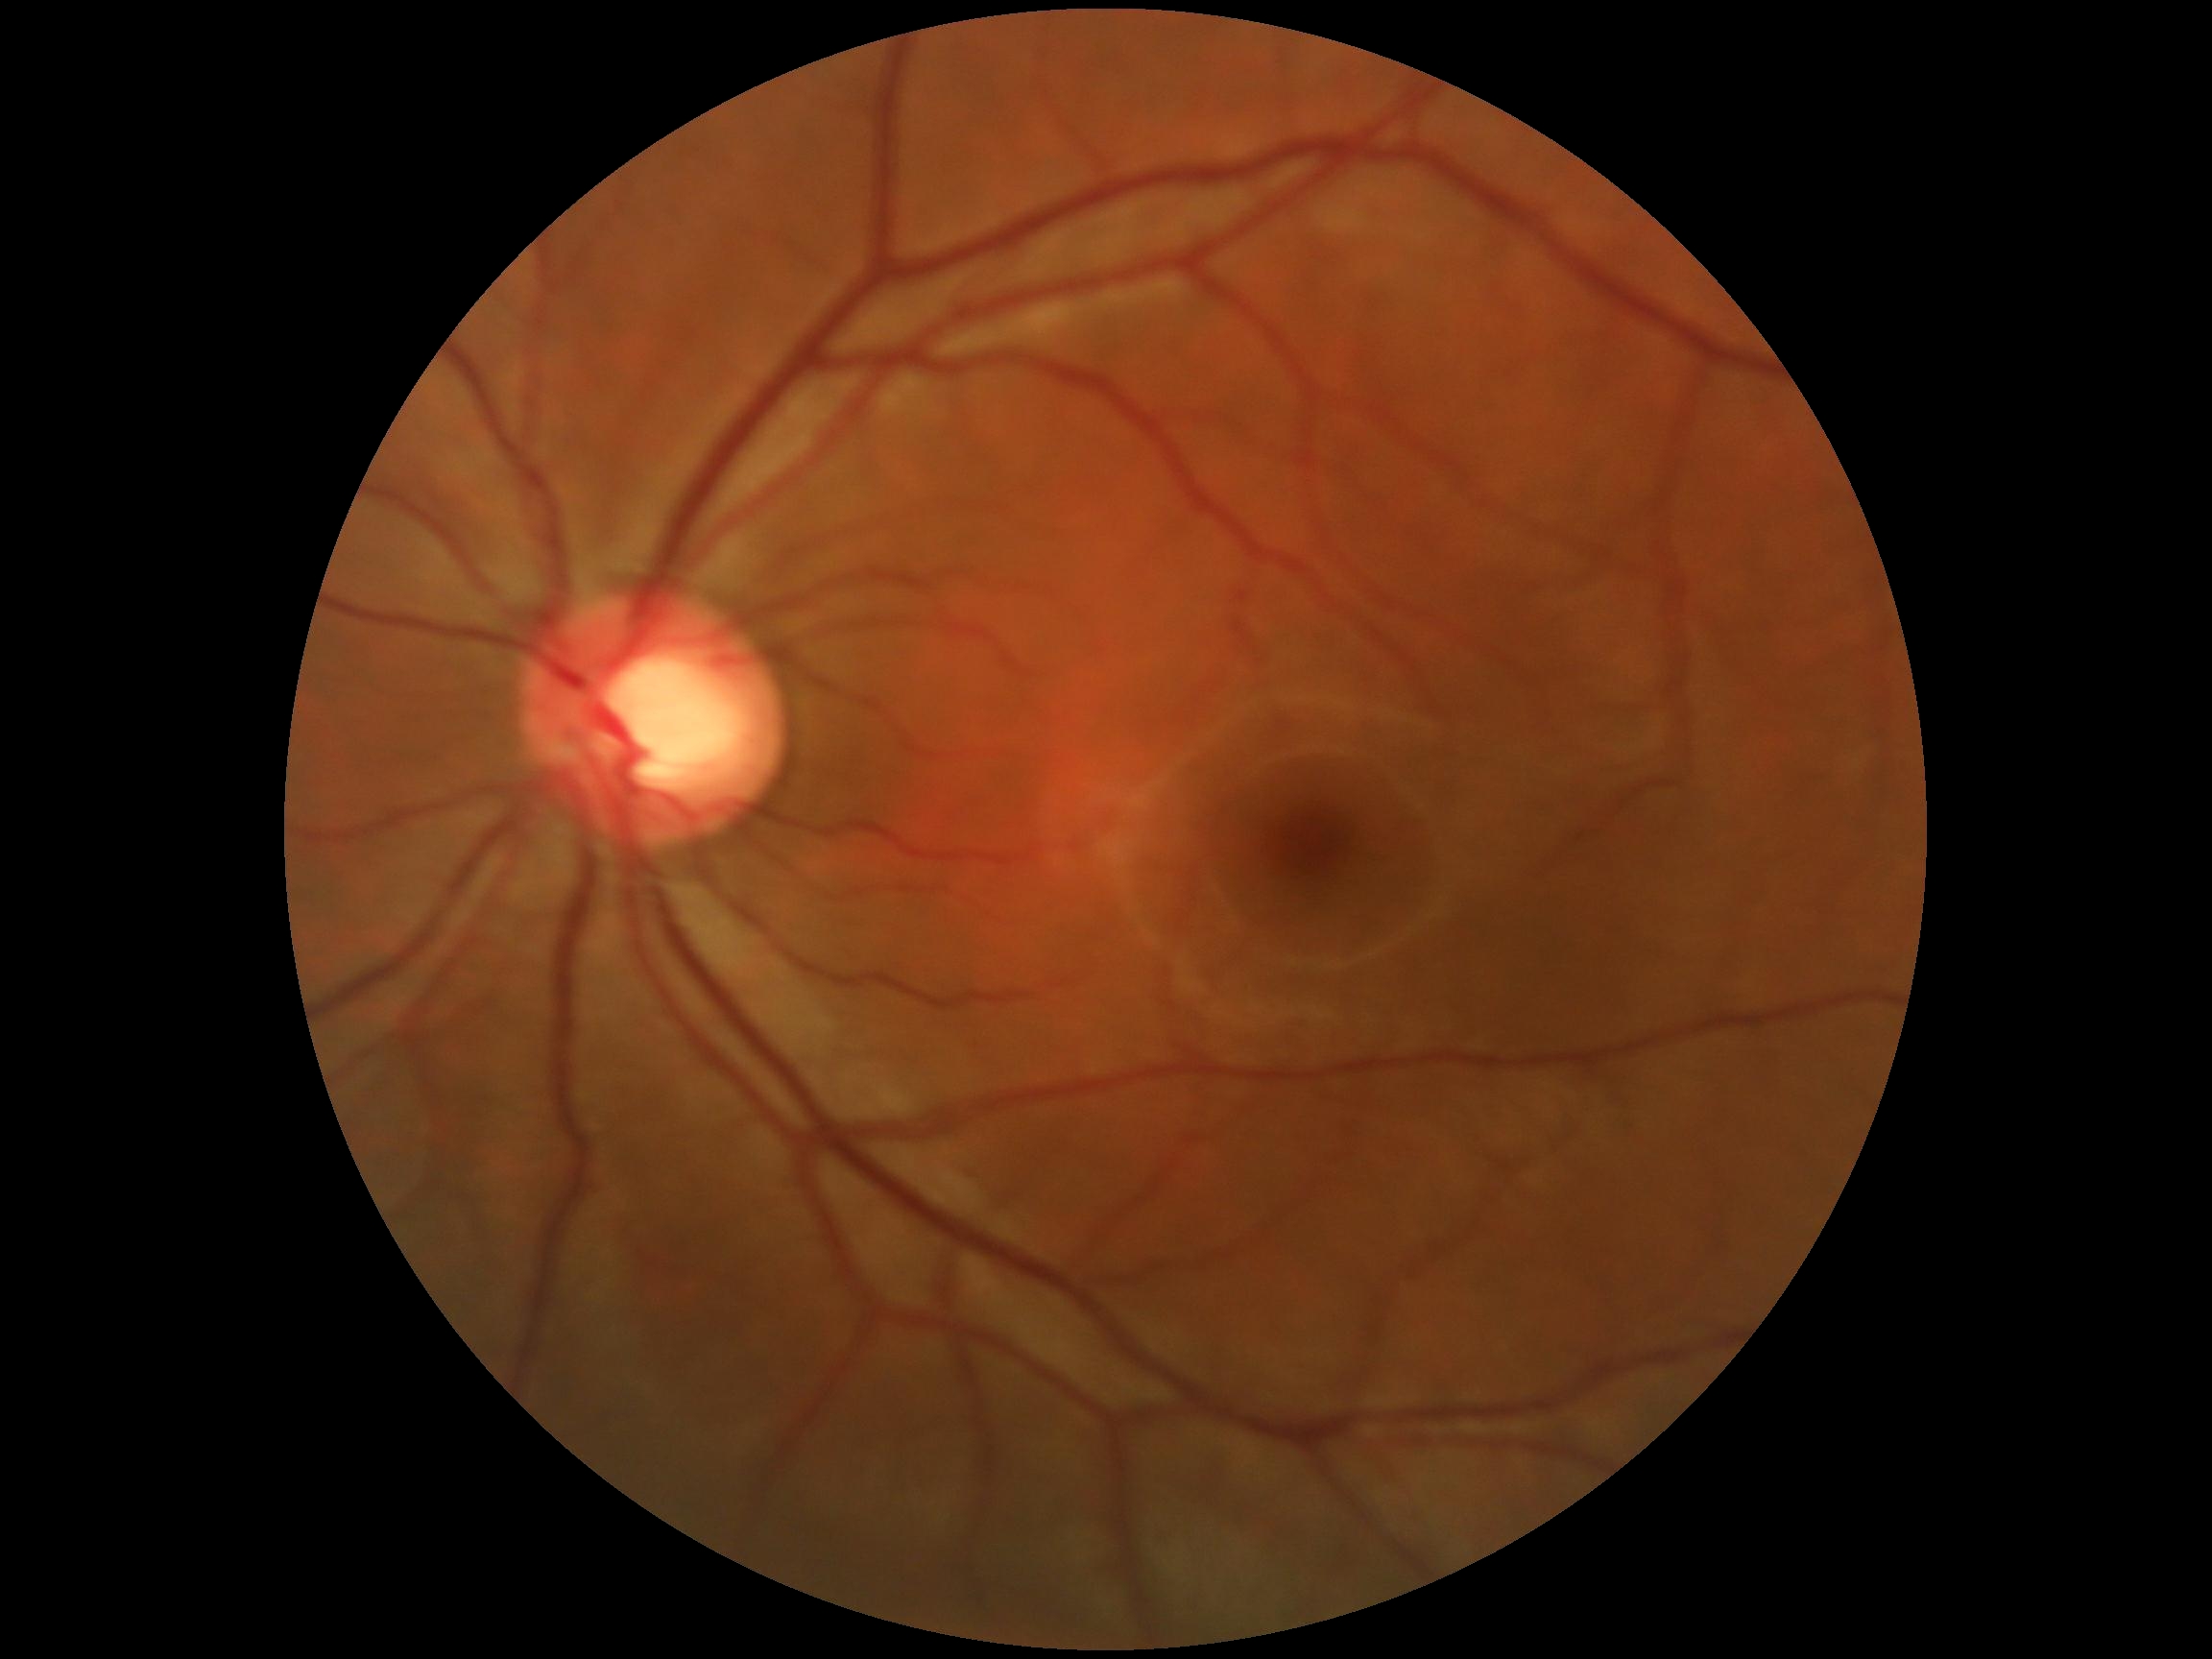
DR stage is no apparent diabetic retinopathy (grade 0).
No signs of diabetic retinopathy.